2089 x 1764 pixels; retinal fundus photograph — 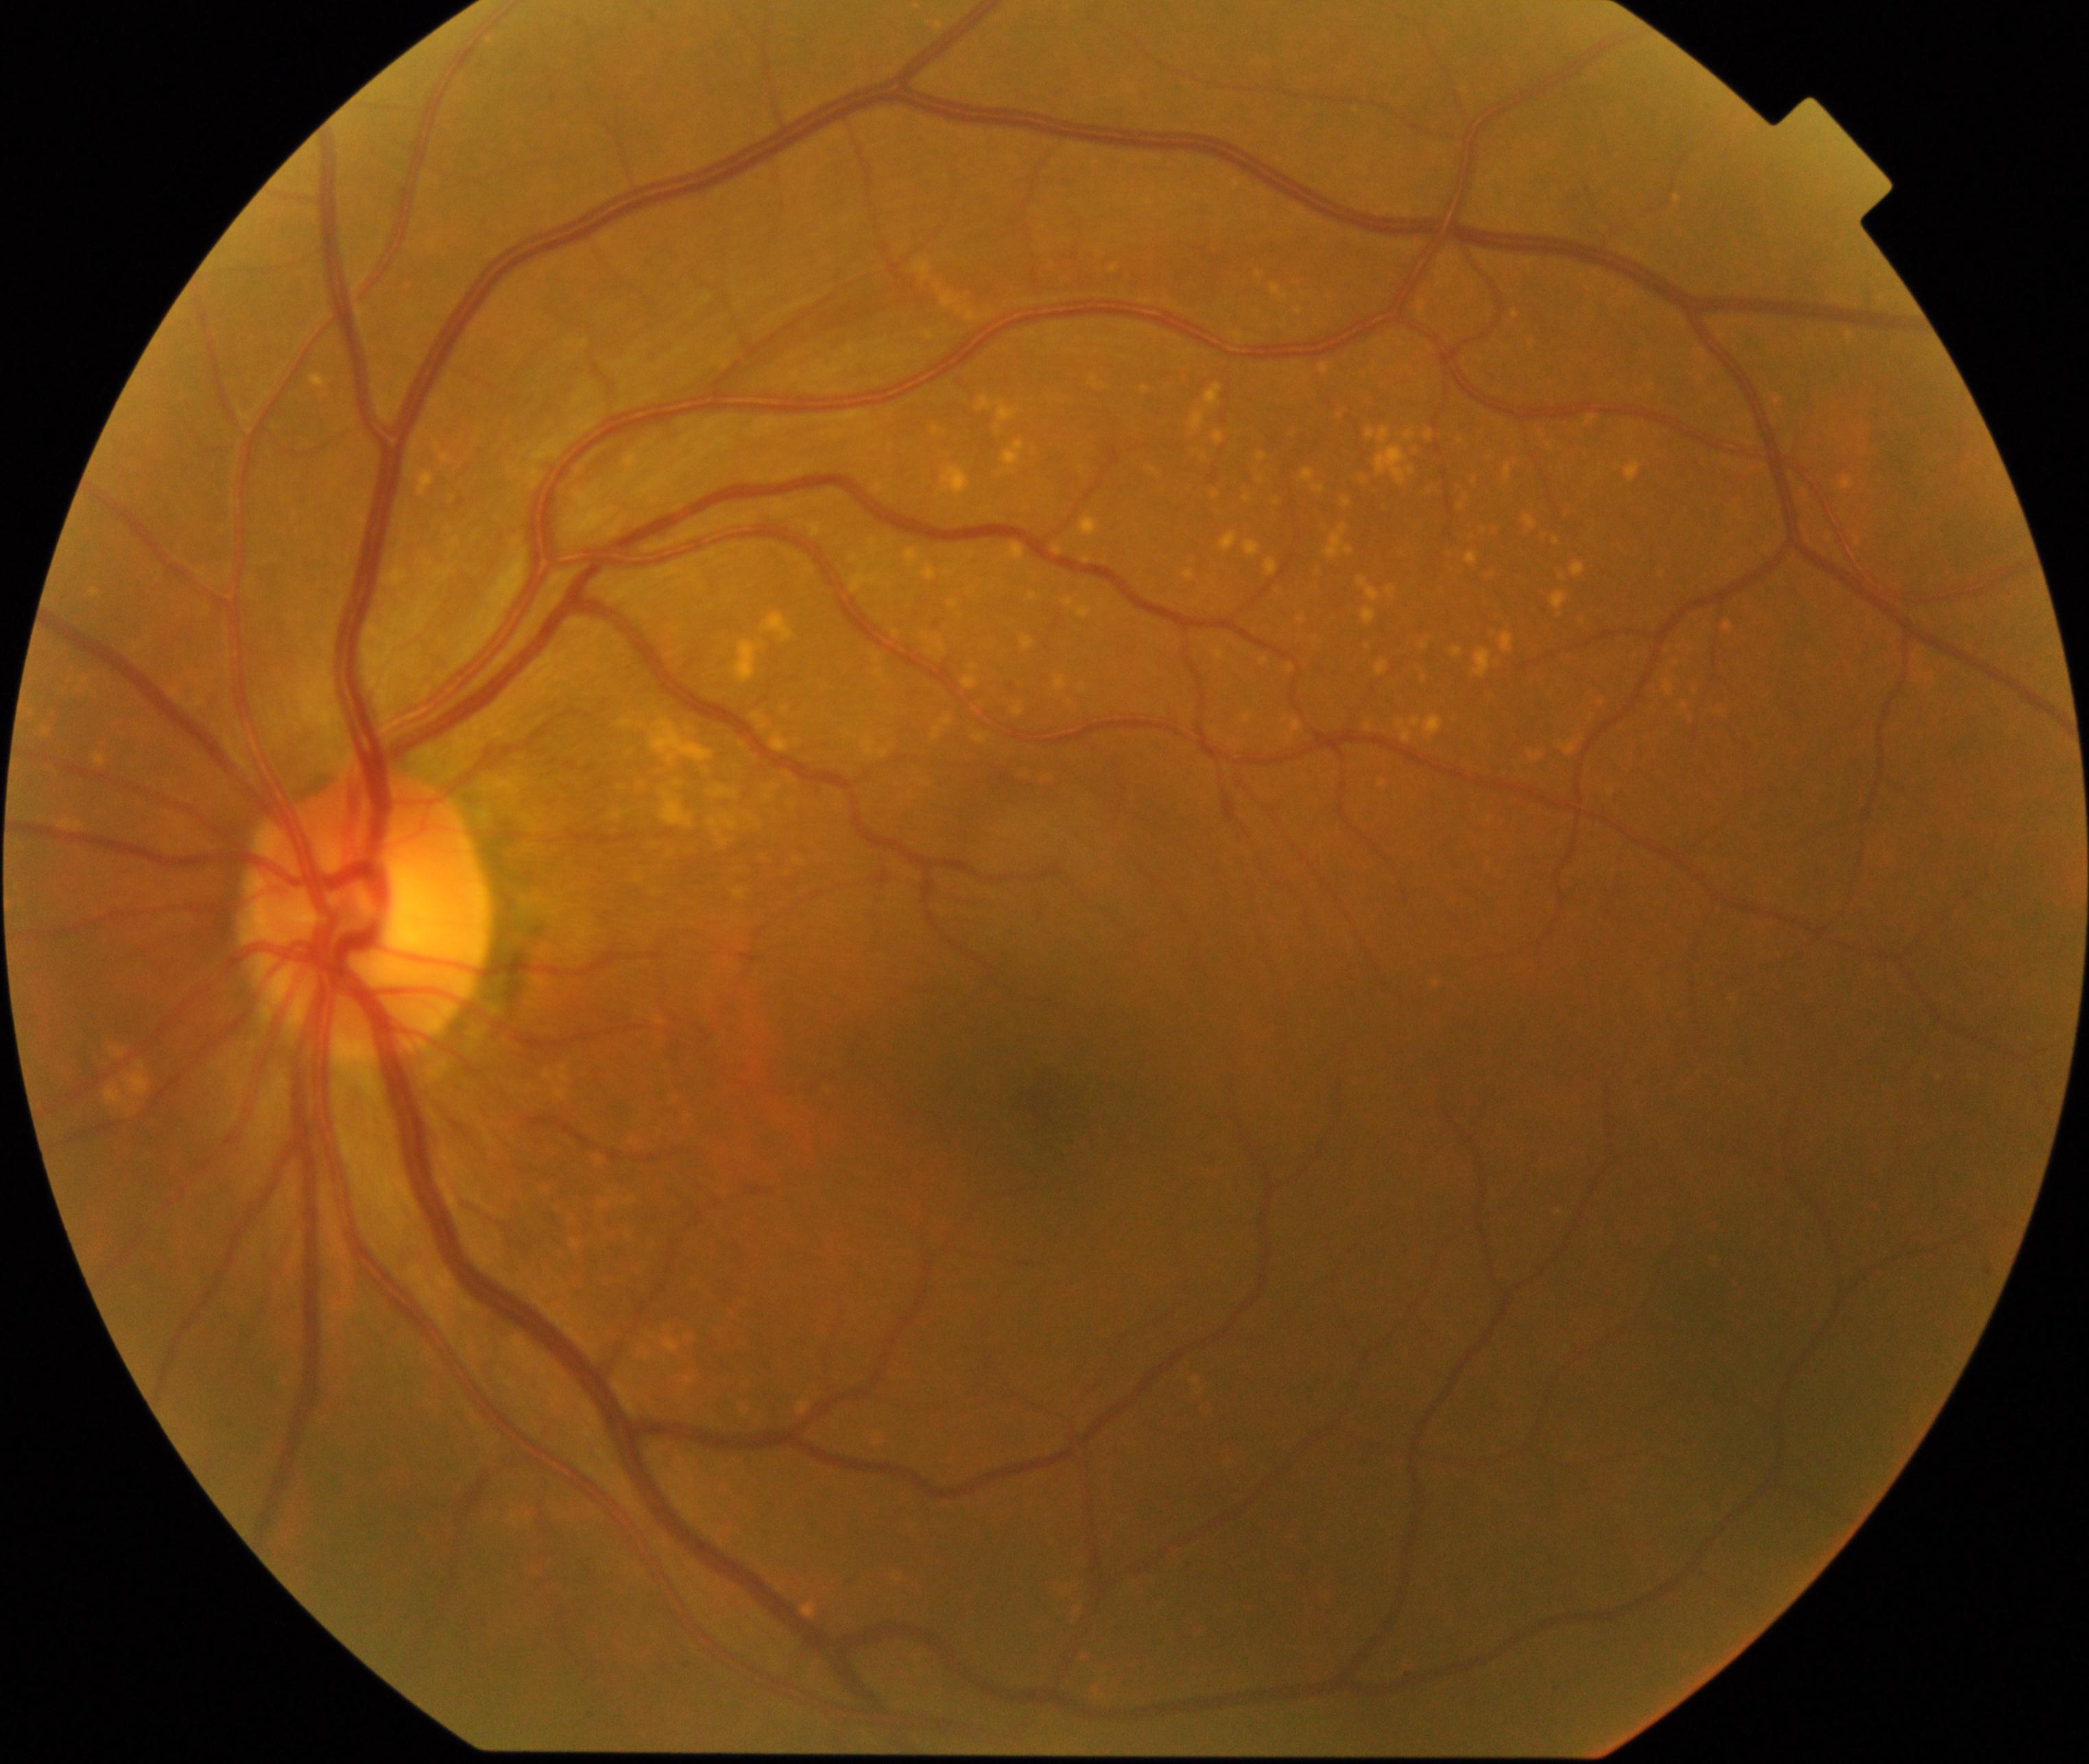

Consistent with yellow-white spots or flecks.